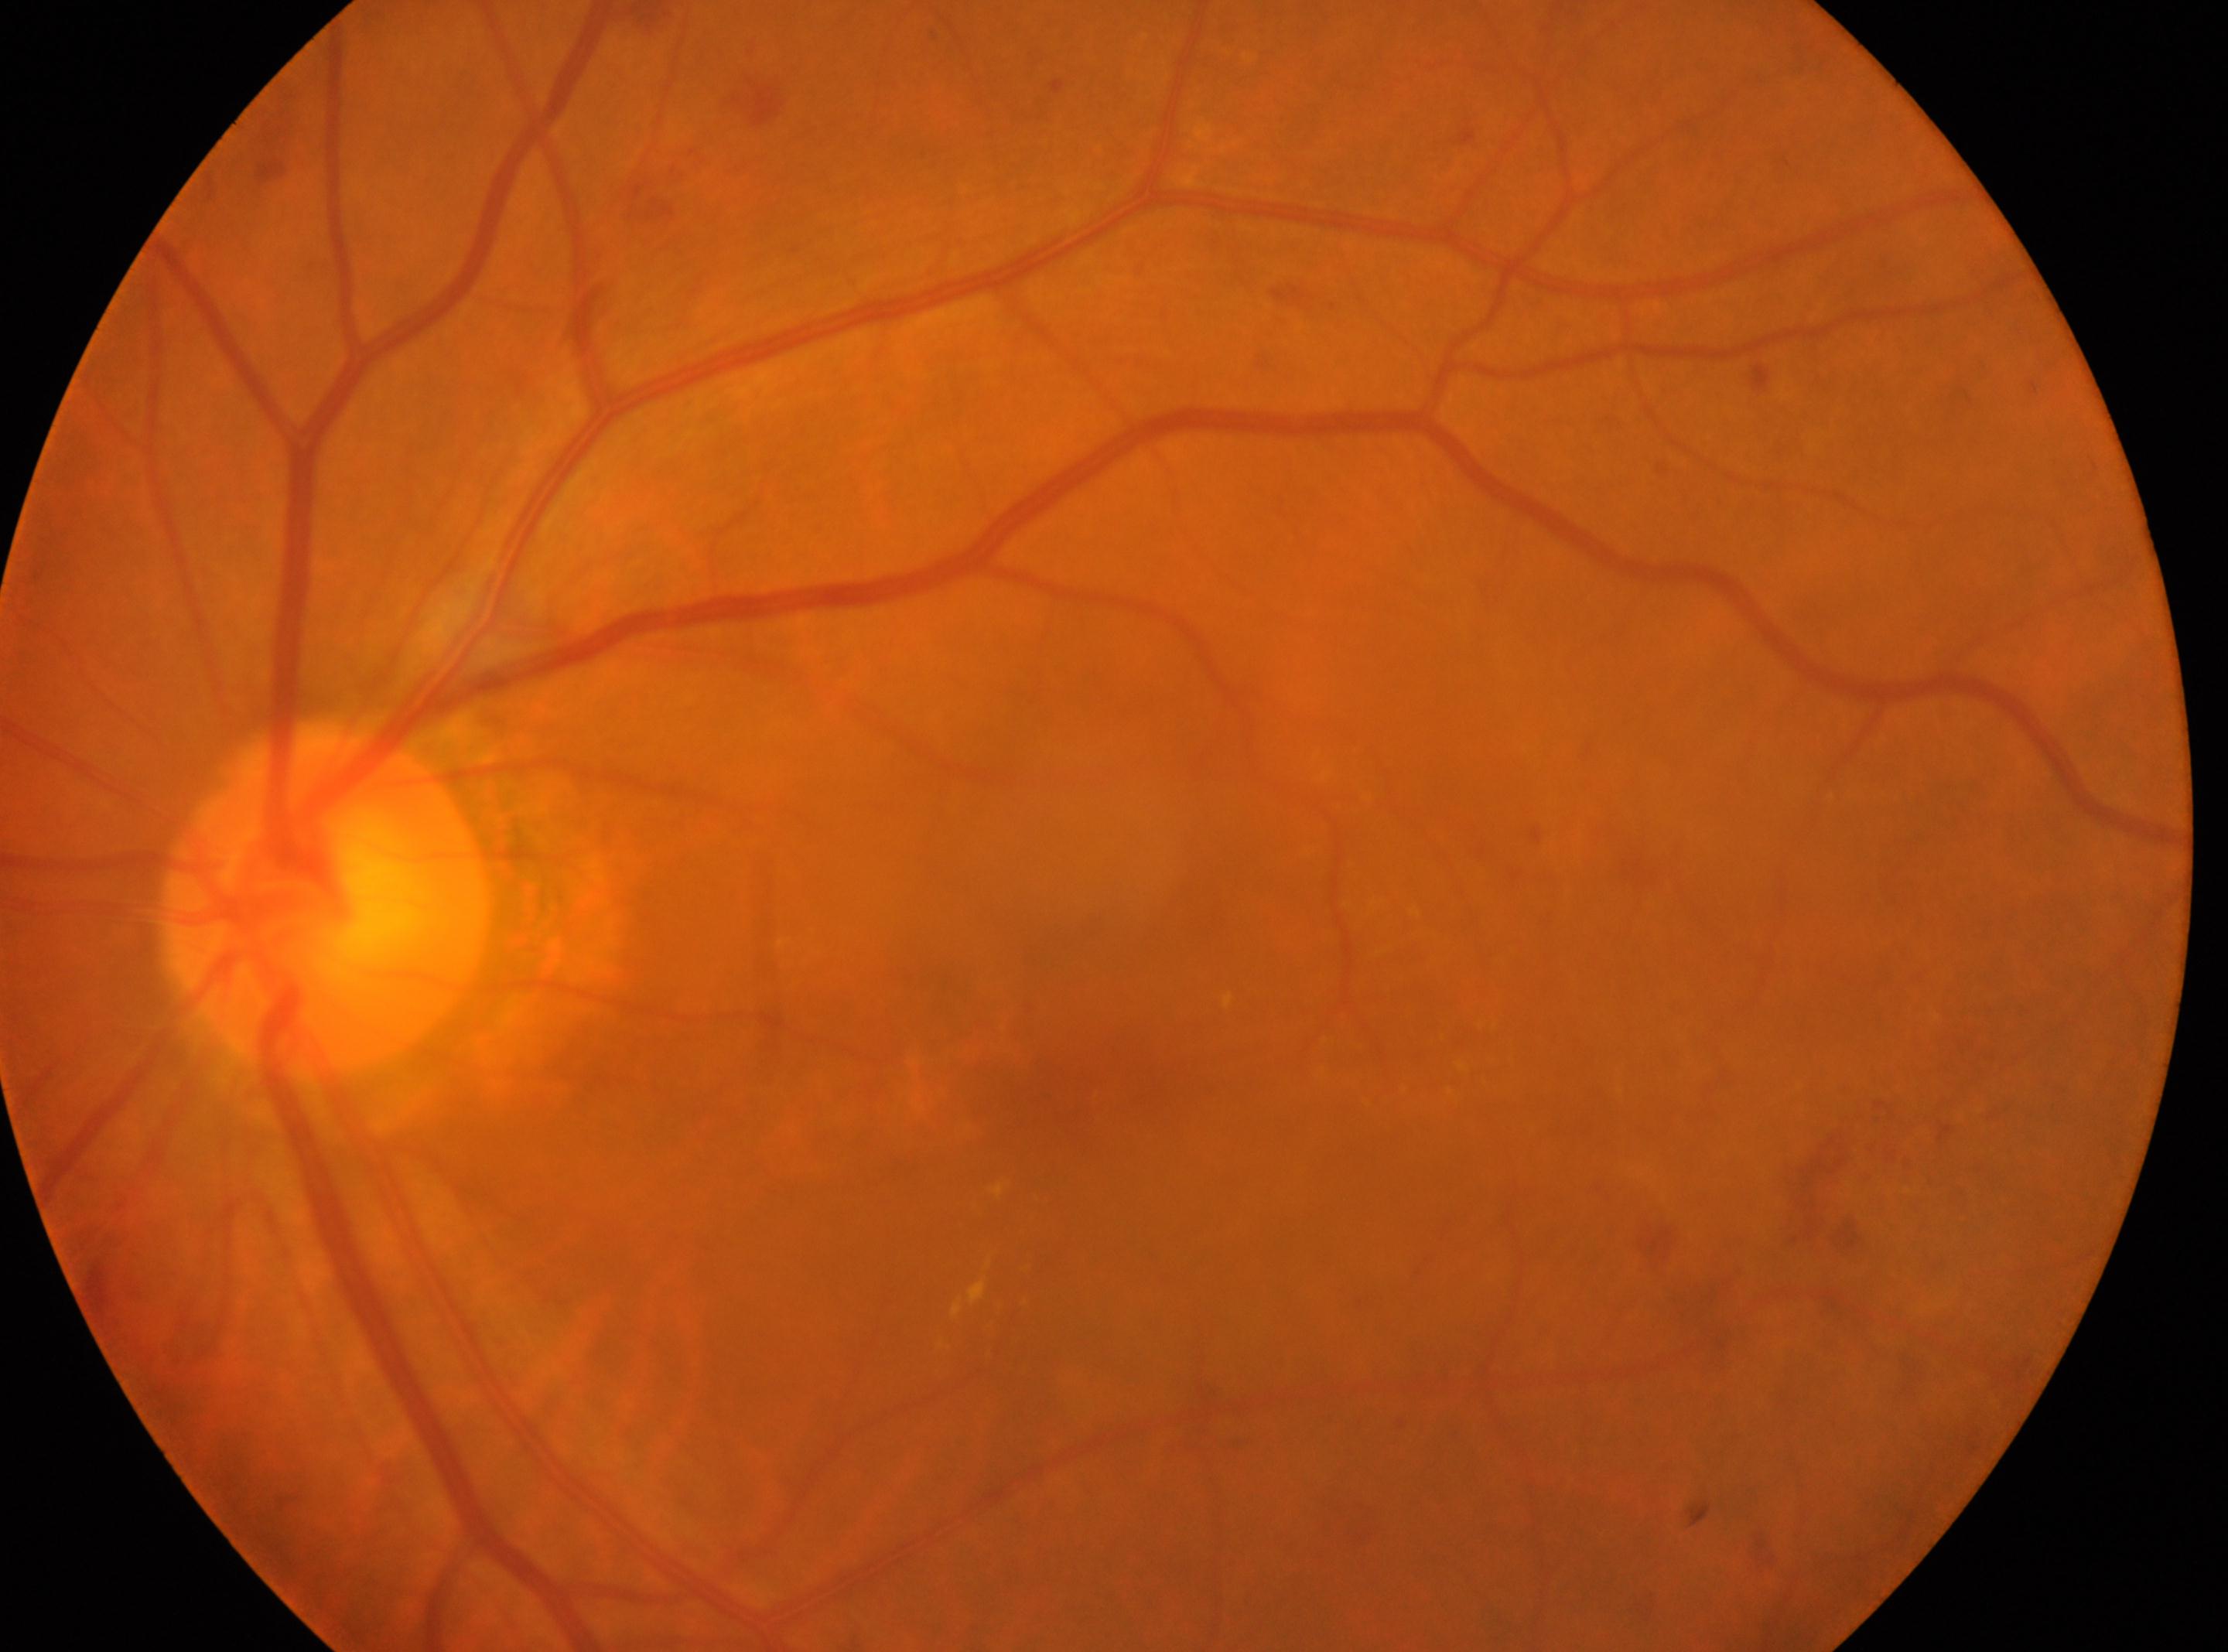

Disc center located at 326px, 899px. The image shows the left eye. The fovea is at 1049px, 1078px. Diabetic retinopathy severity is 2.